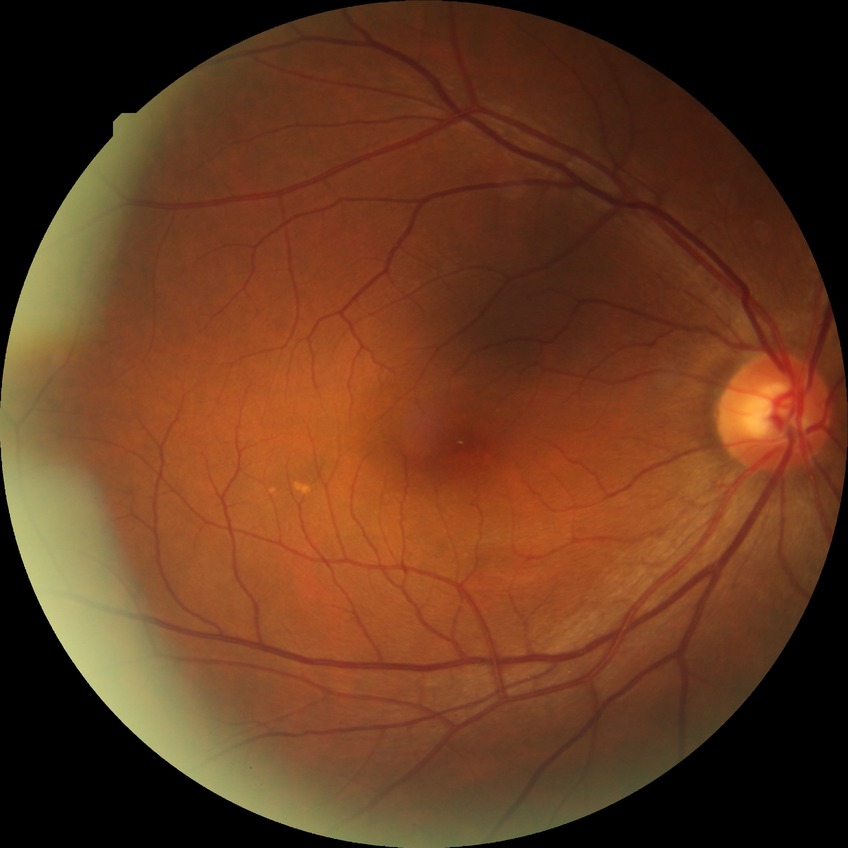
{
  "davis_grade": "NDR (no diabetic retinopathy)"
}